45° FOV, graded on the modified Davis scale, CFP, nonmydriatic, camera: NIDEK AFC-230
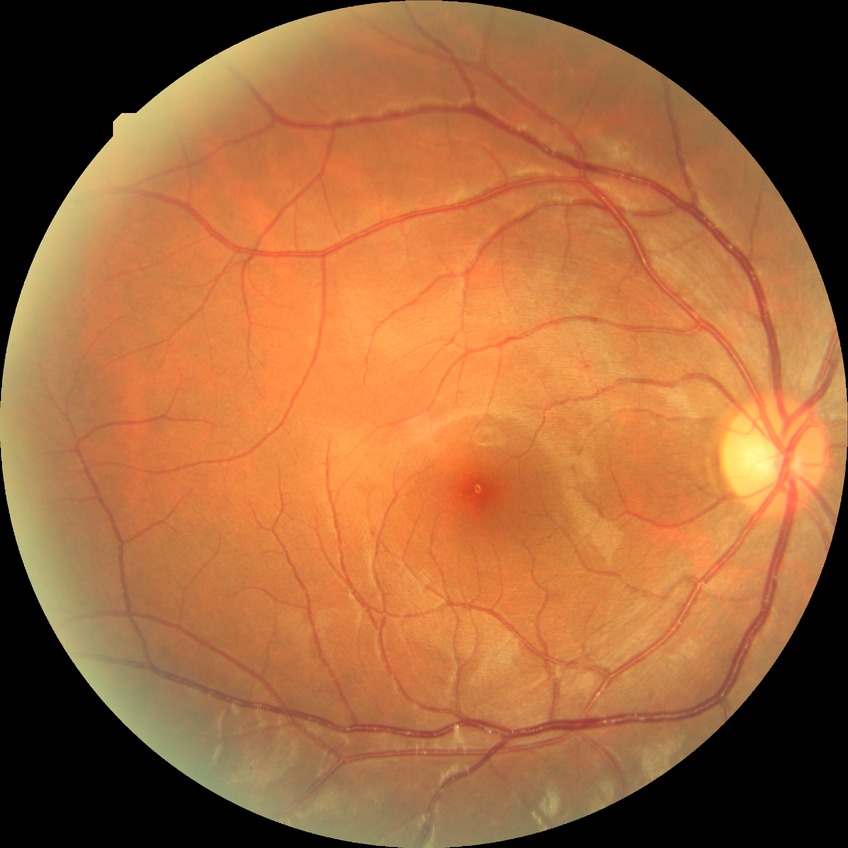

diabetic retinopathy severity=no diabetic retinopathy.